Infant wide-field retinal image · acquired on the Phoenix ICON · image size 1240x1240: 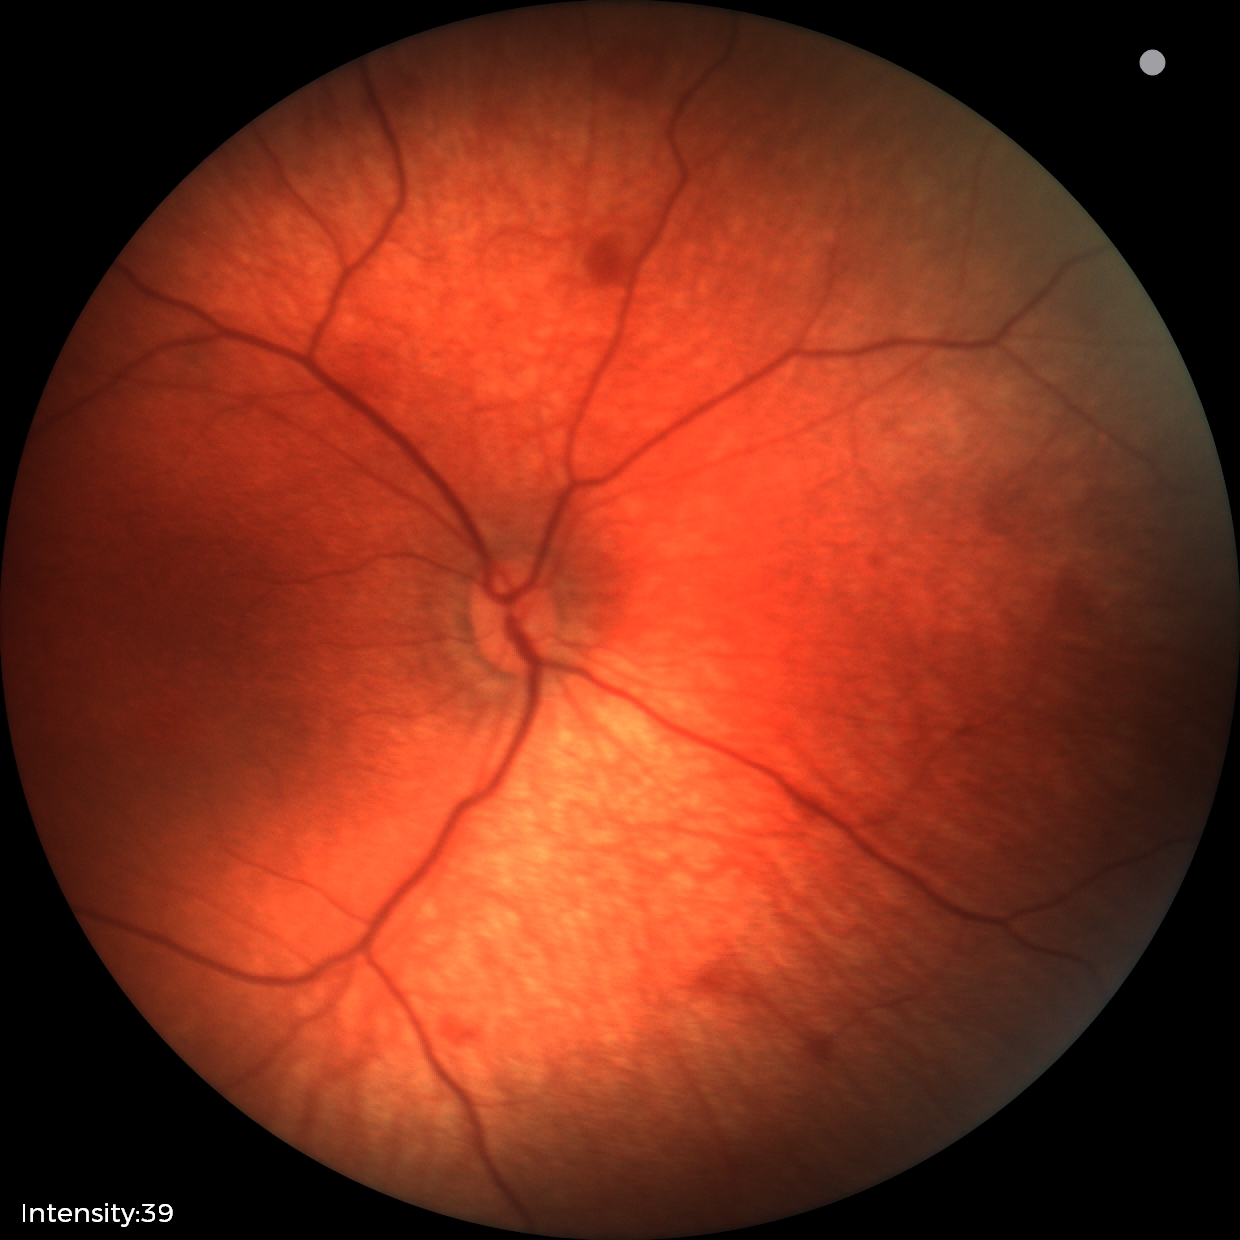

From an examination with diagnosis of retinal hemorrhages.